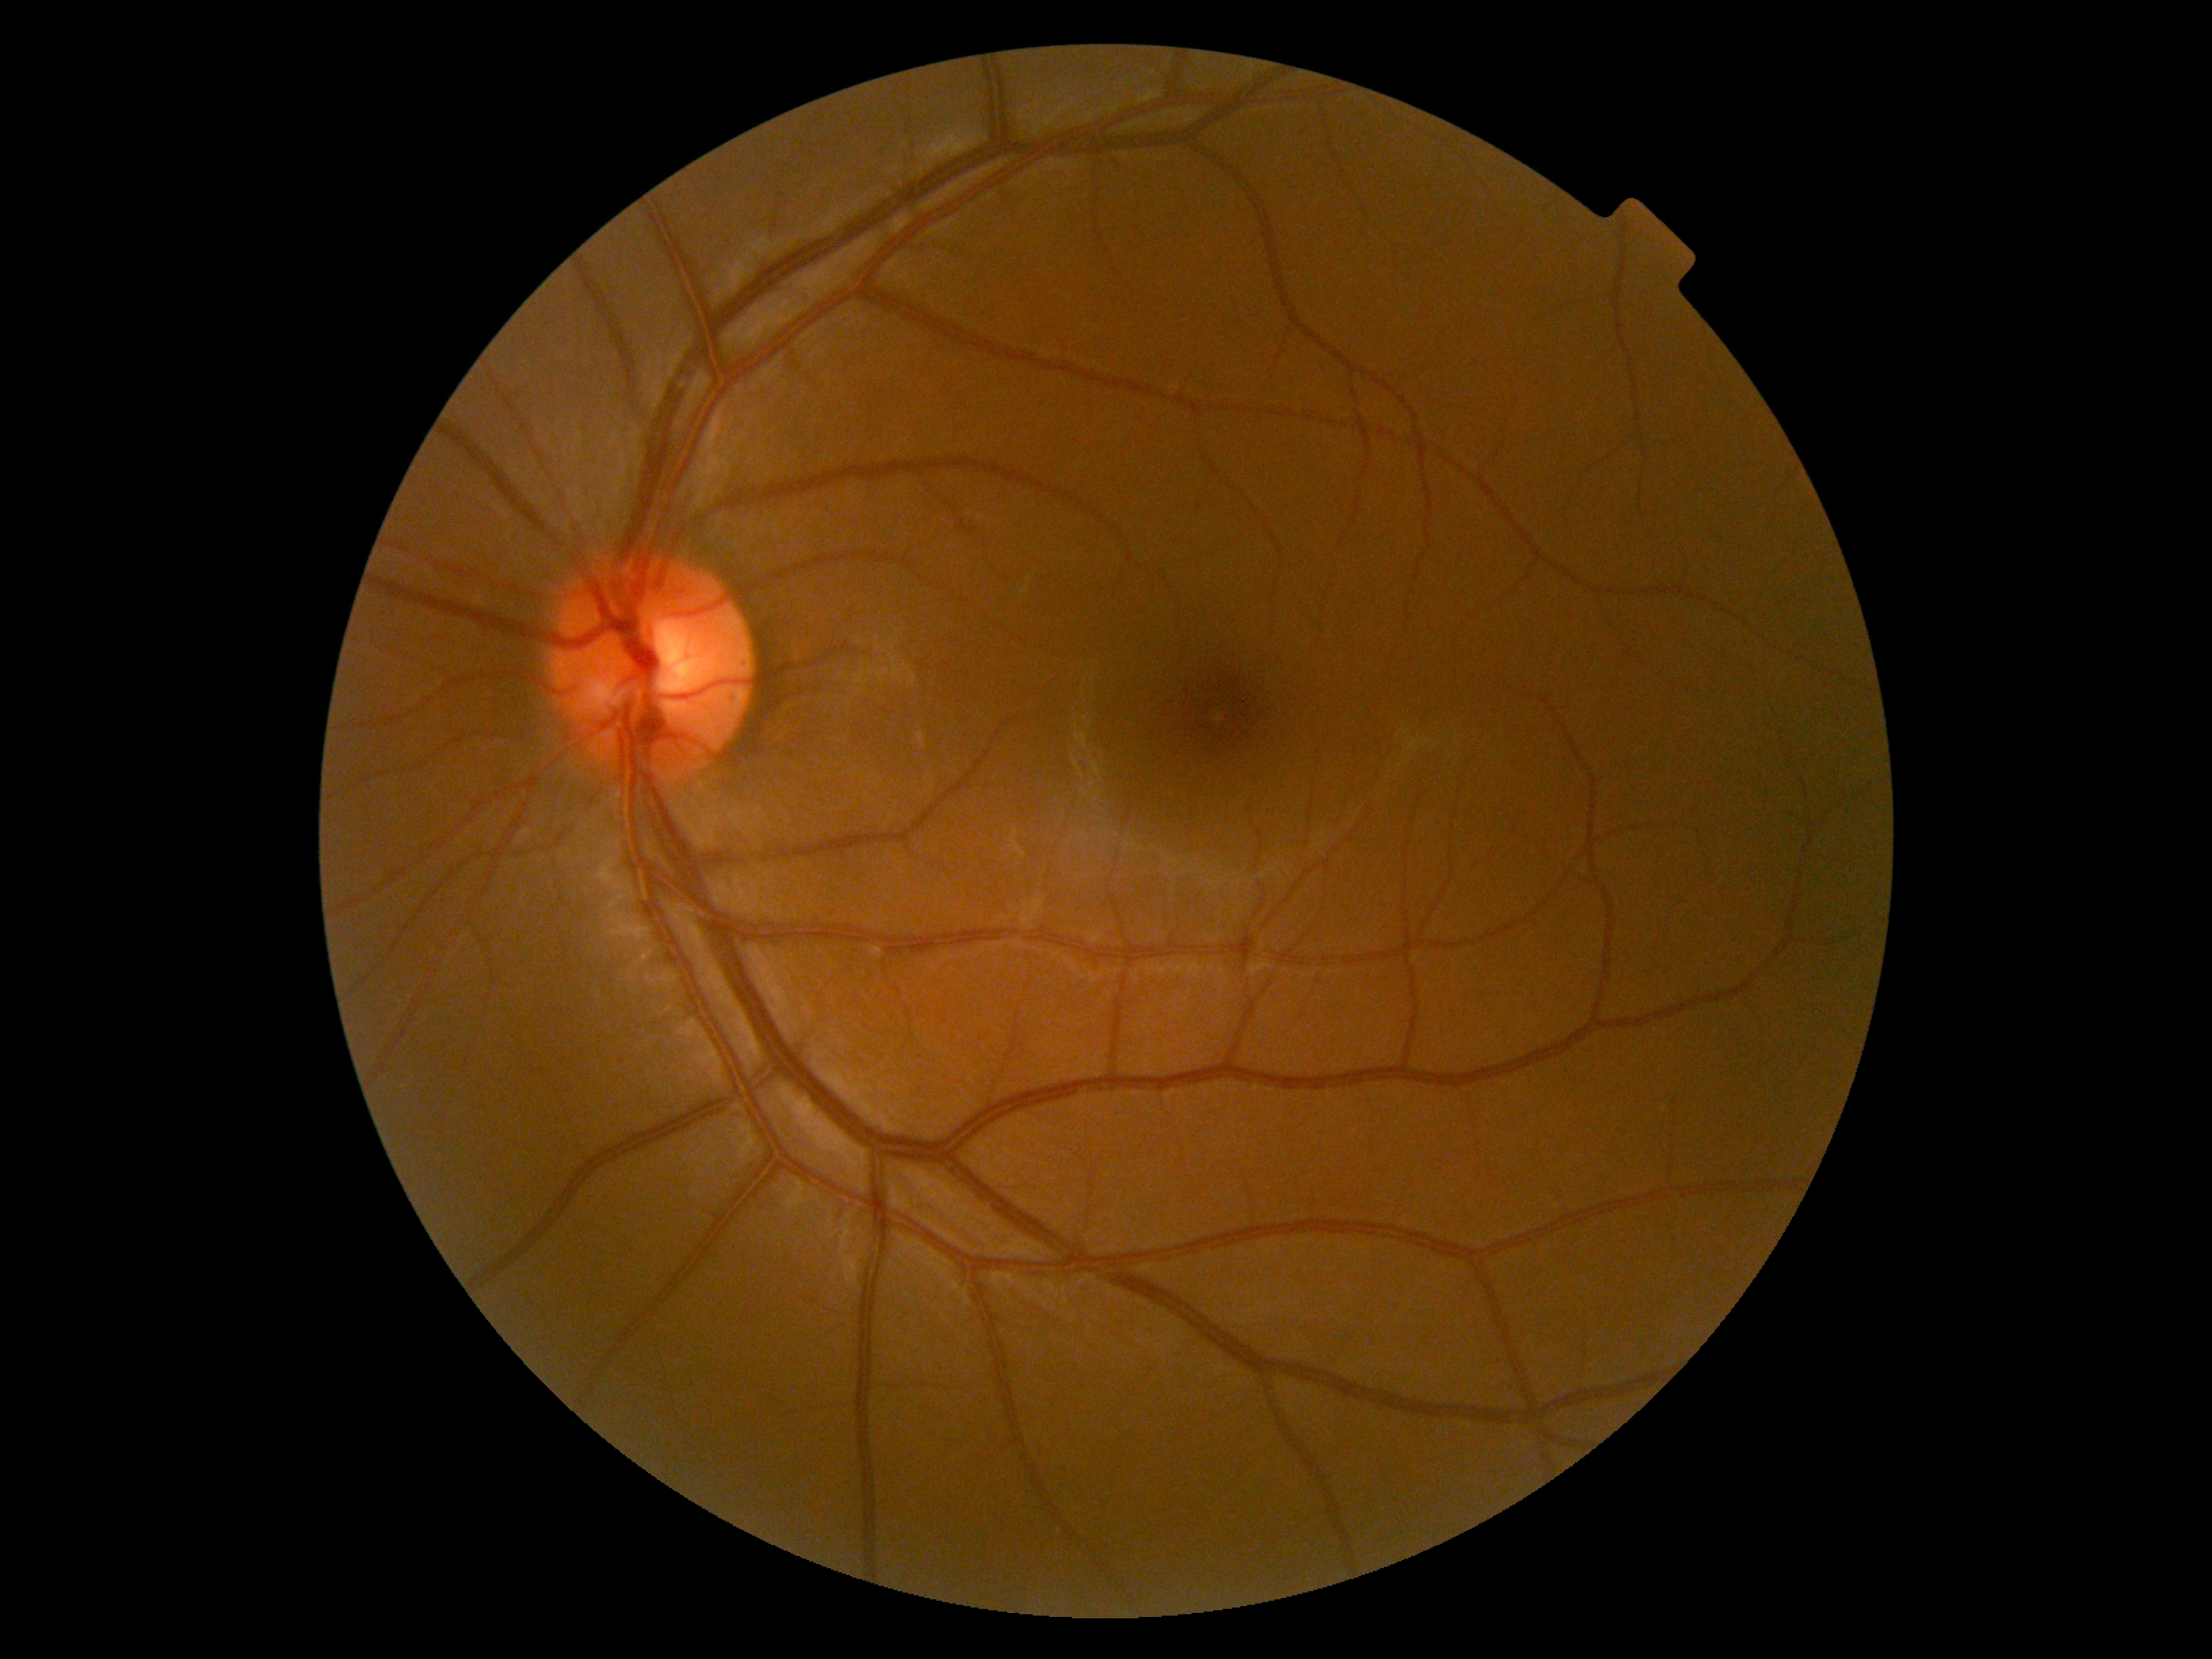 Retinopathy: no apparent retinopathy (grade 0).